Wide-field contact fundus photograph of an infant · camera: Clarity RetCam 3 (130° FOV) · 640 by 480 pixels:
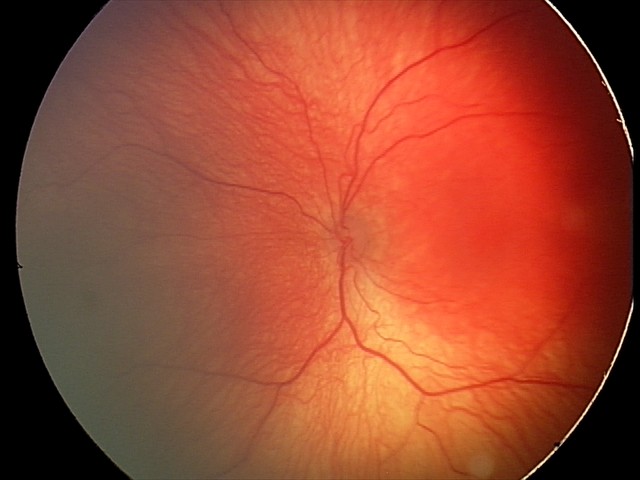
Plus form = absent — posterior pole vessels without abnormal dilation or tortuosity, assessment = retinopathy of prematurity stage 2.